2212x1659px, FOV: 45 degrees, retinal fundus photograph: 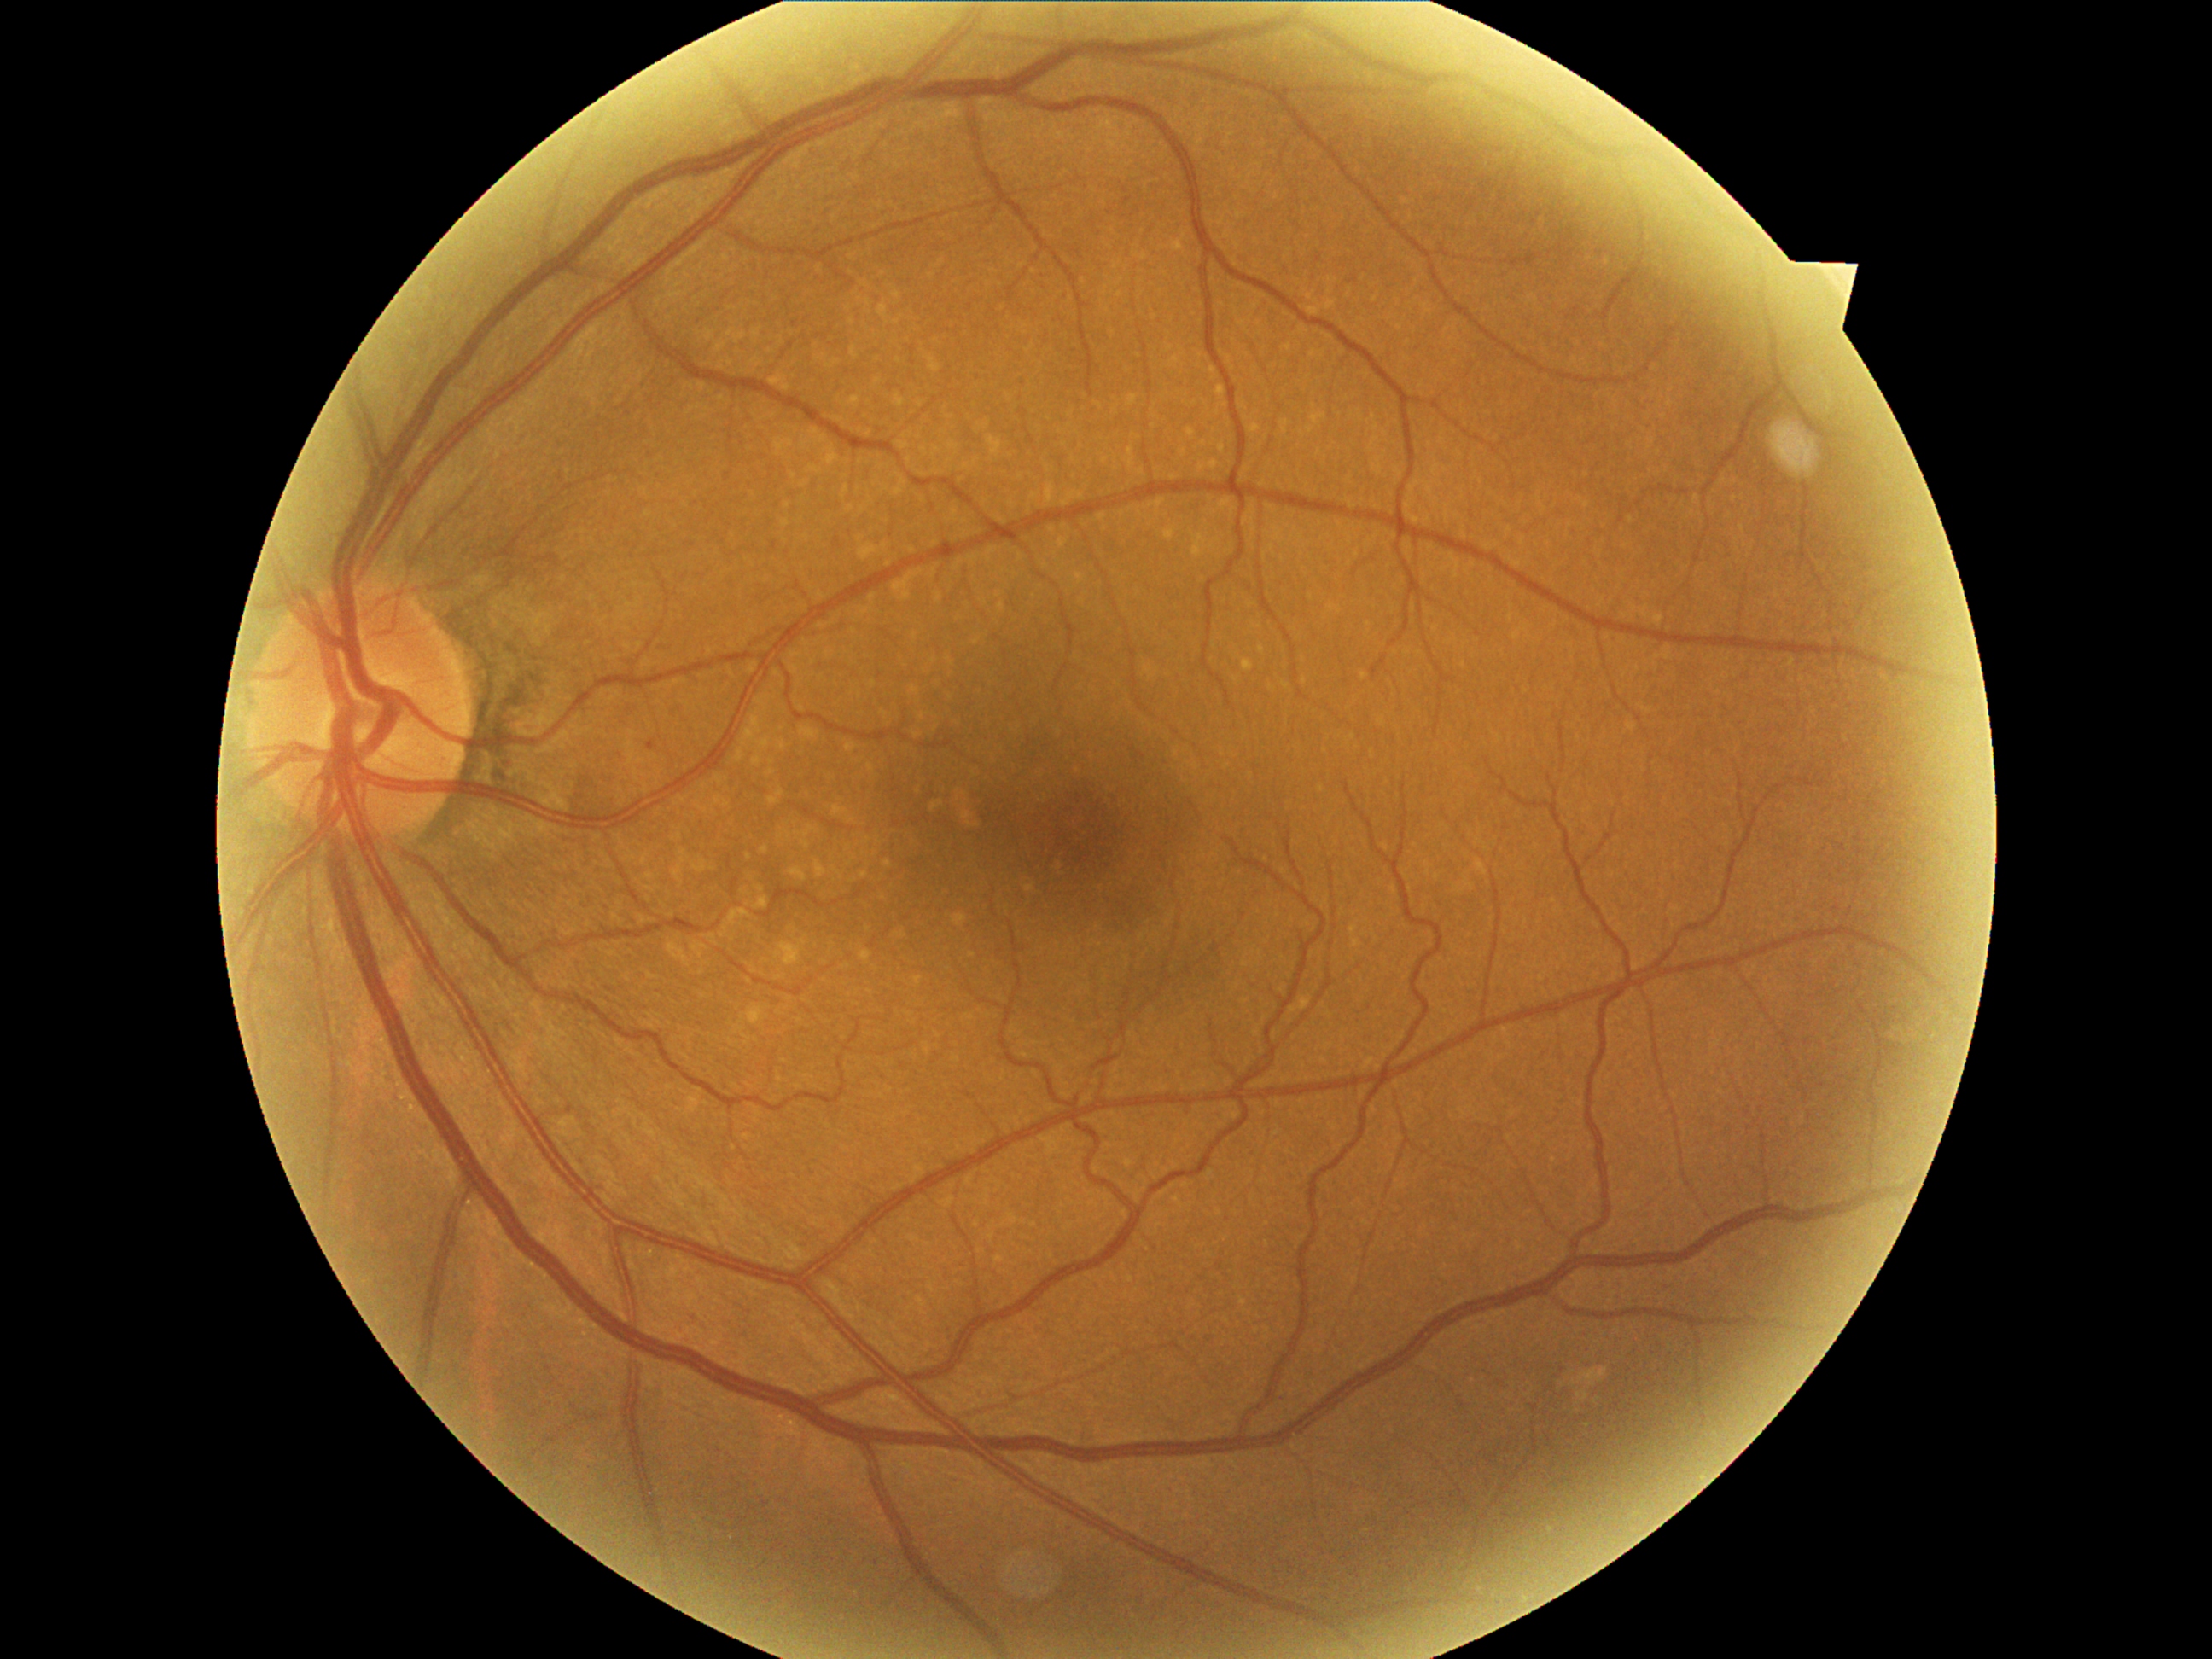
DR: grade 1.